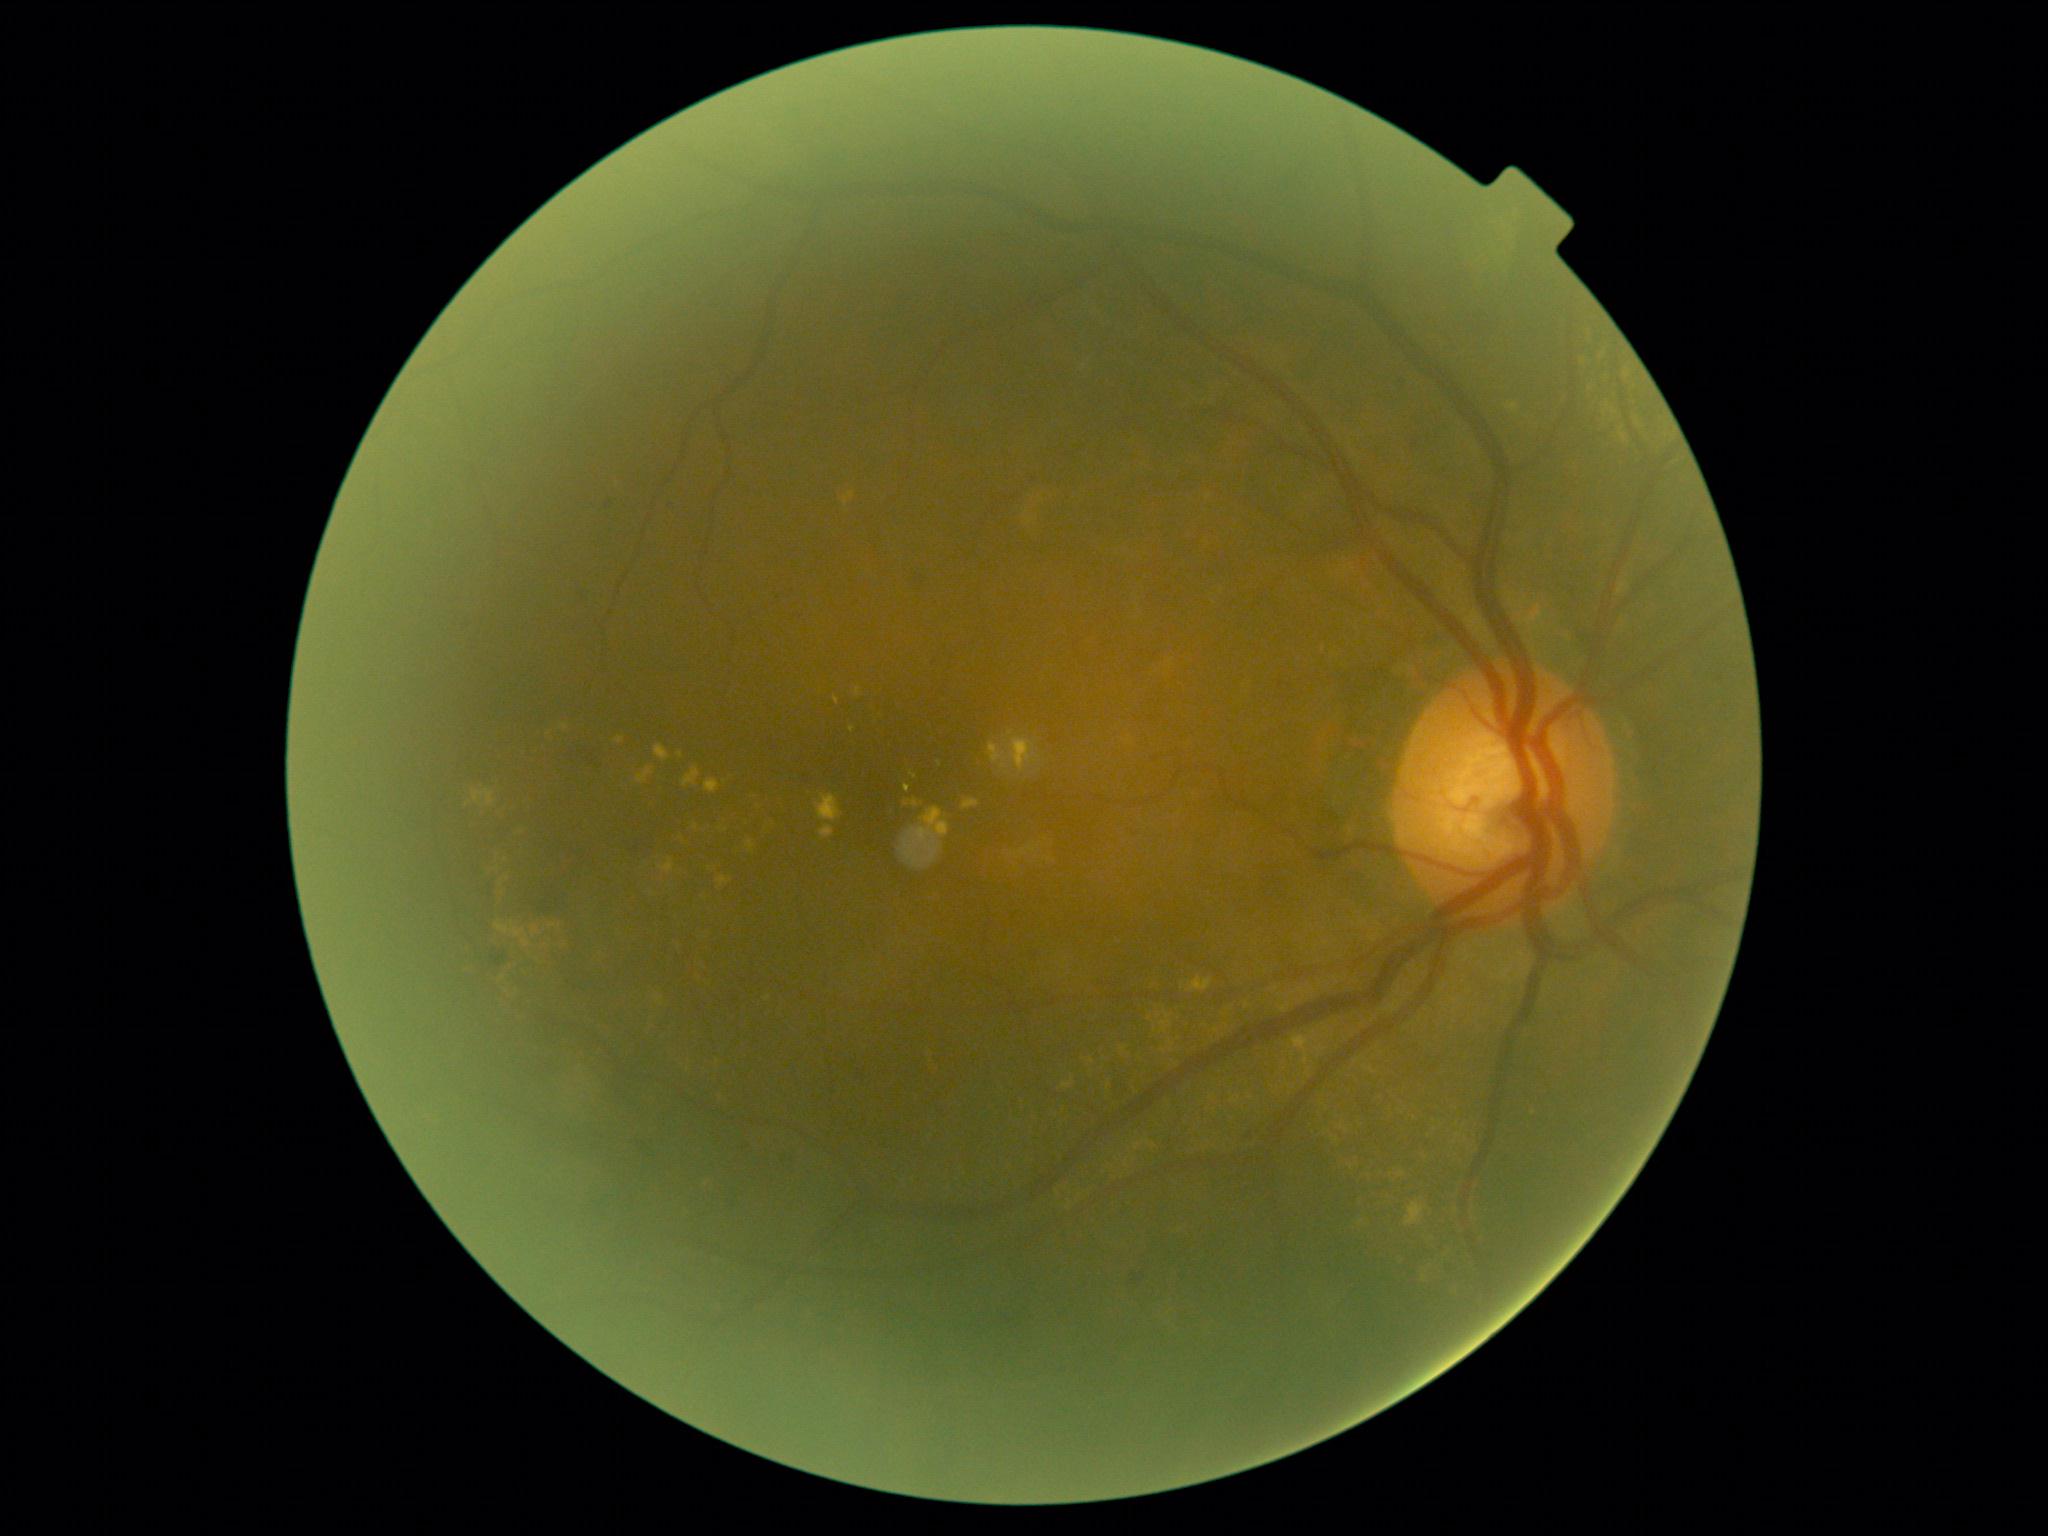

Diabetic retinopathy: grade 2 (moderate NPDR).